Posterior pole photograph; modified Davis classification
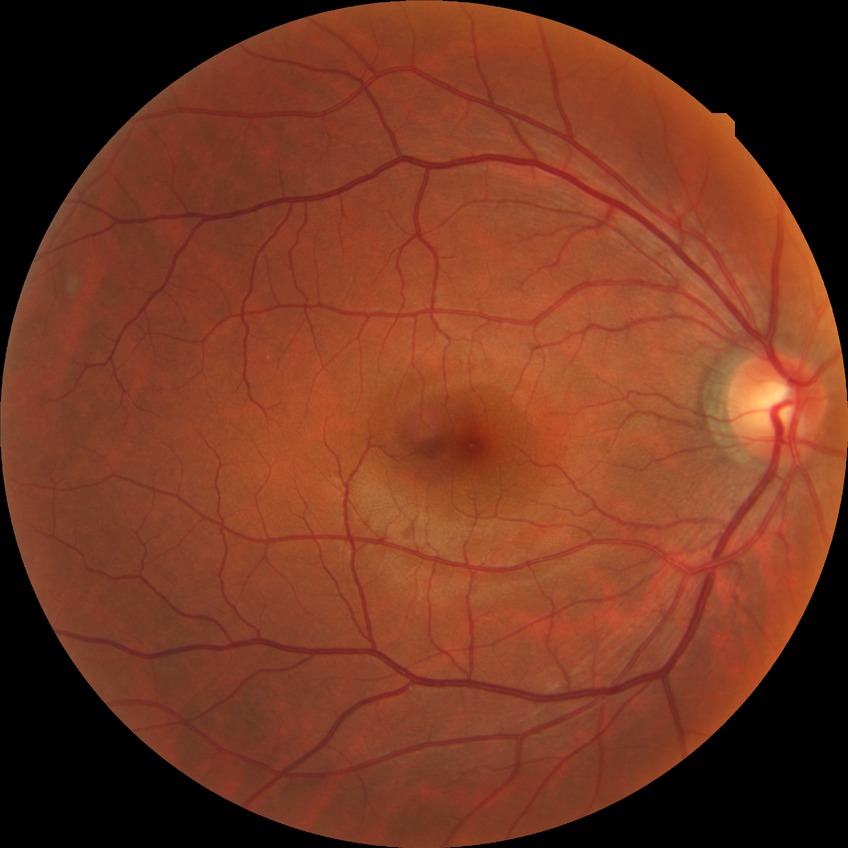

Diabetic retinopathy (DR) is NDR (no diabetic retinopathy).